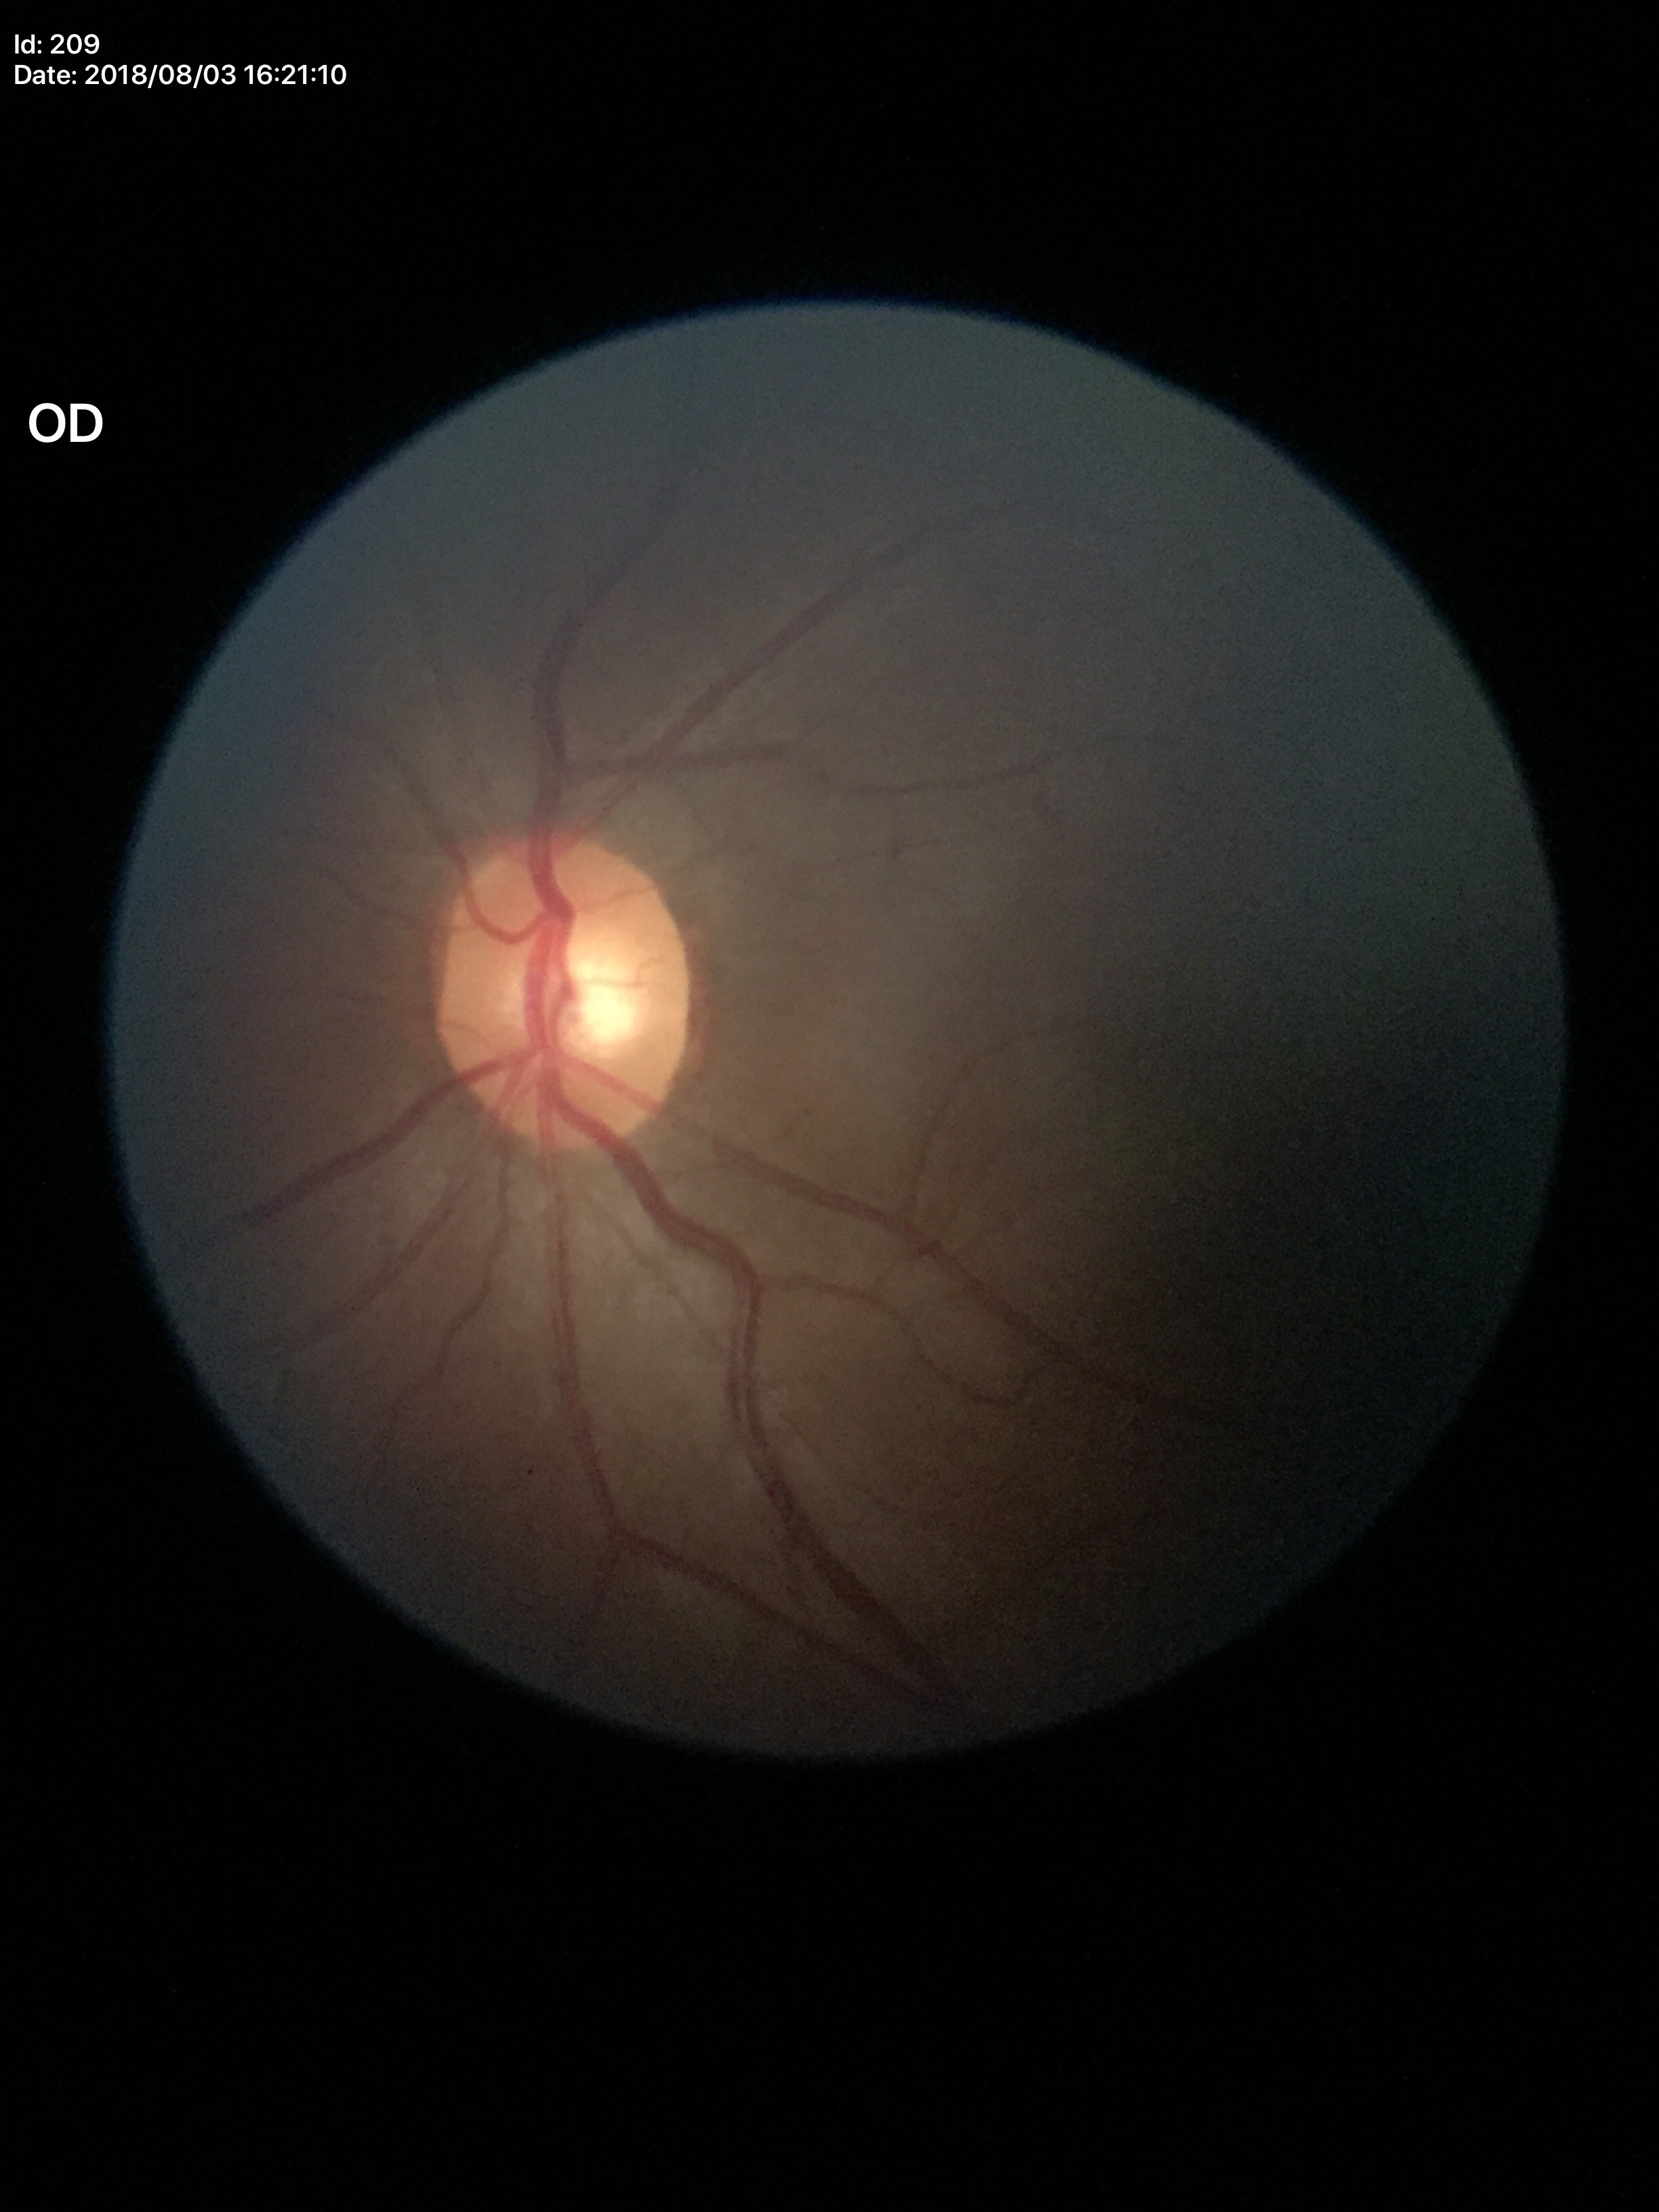
glaucoma_decision: negative
vcdr: 0.47